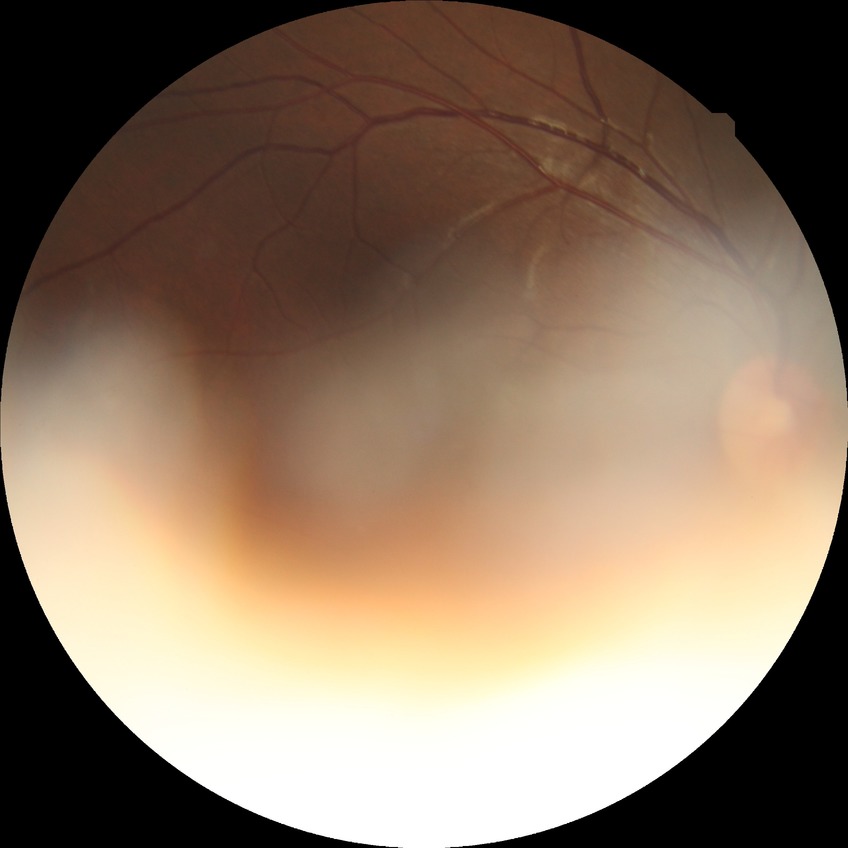
Diabetic retinopathy (DR): no diabetic retinopathy (NDR).